Acquired on the Phoenix ICON; 1240x1240px; wide-field fundus photograph from neonatal ROP screening:
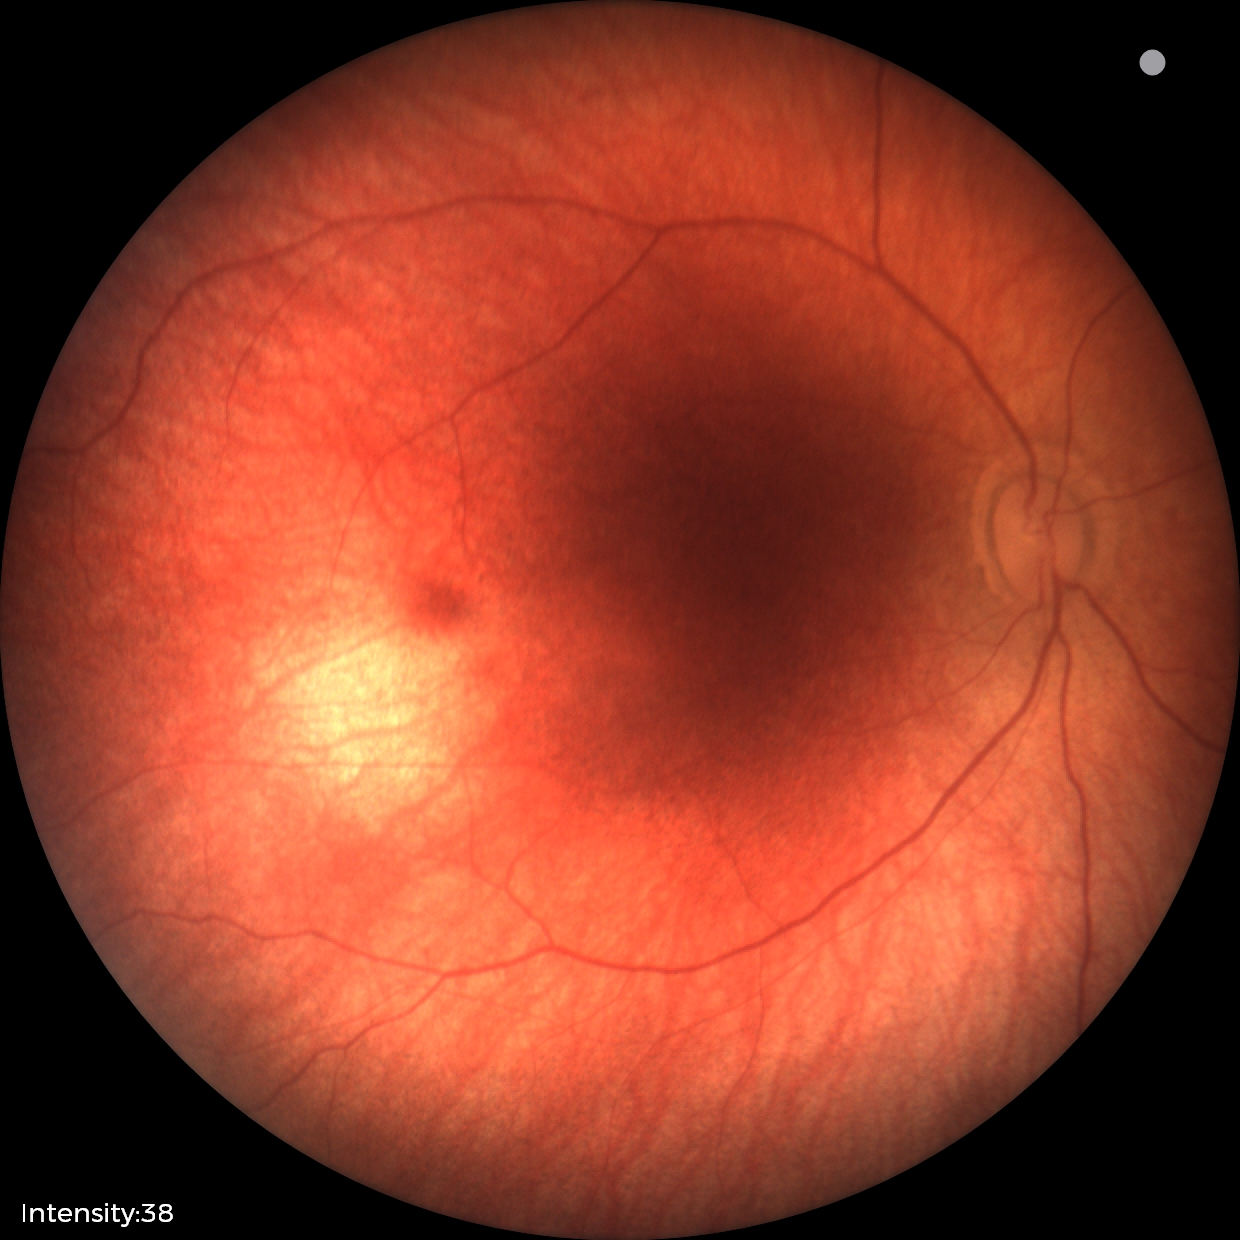
Q: What is the screening diagnosis?
A: normal retinal appearance